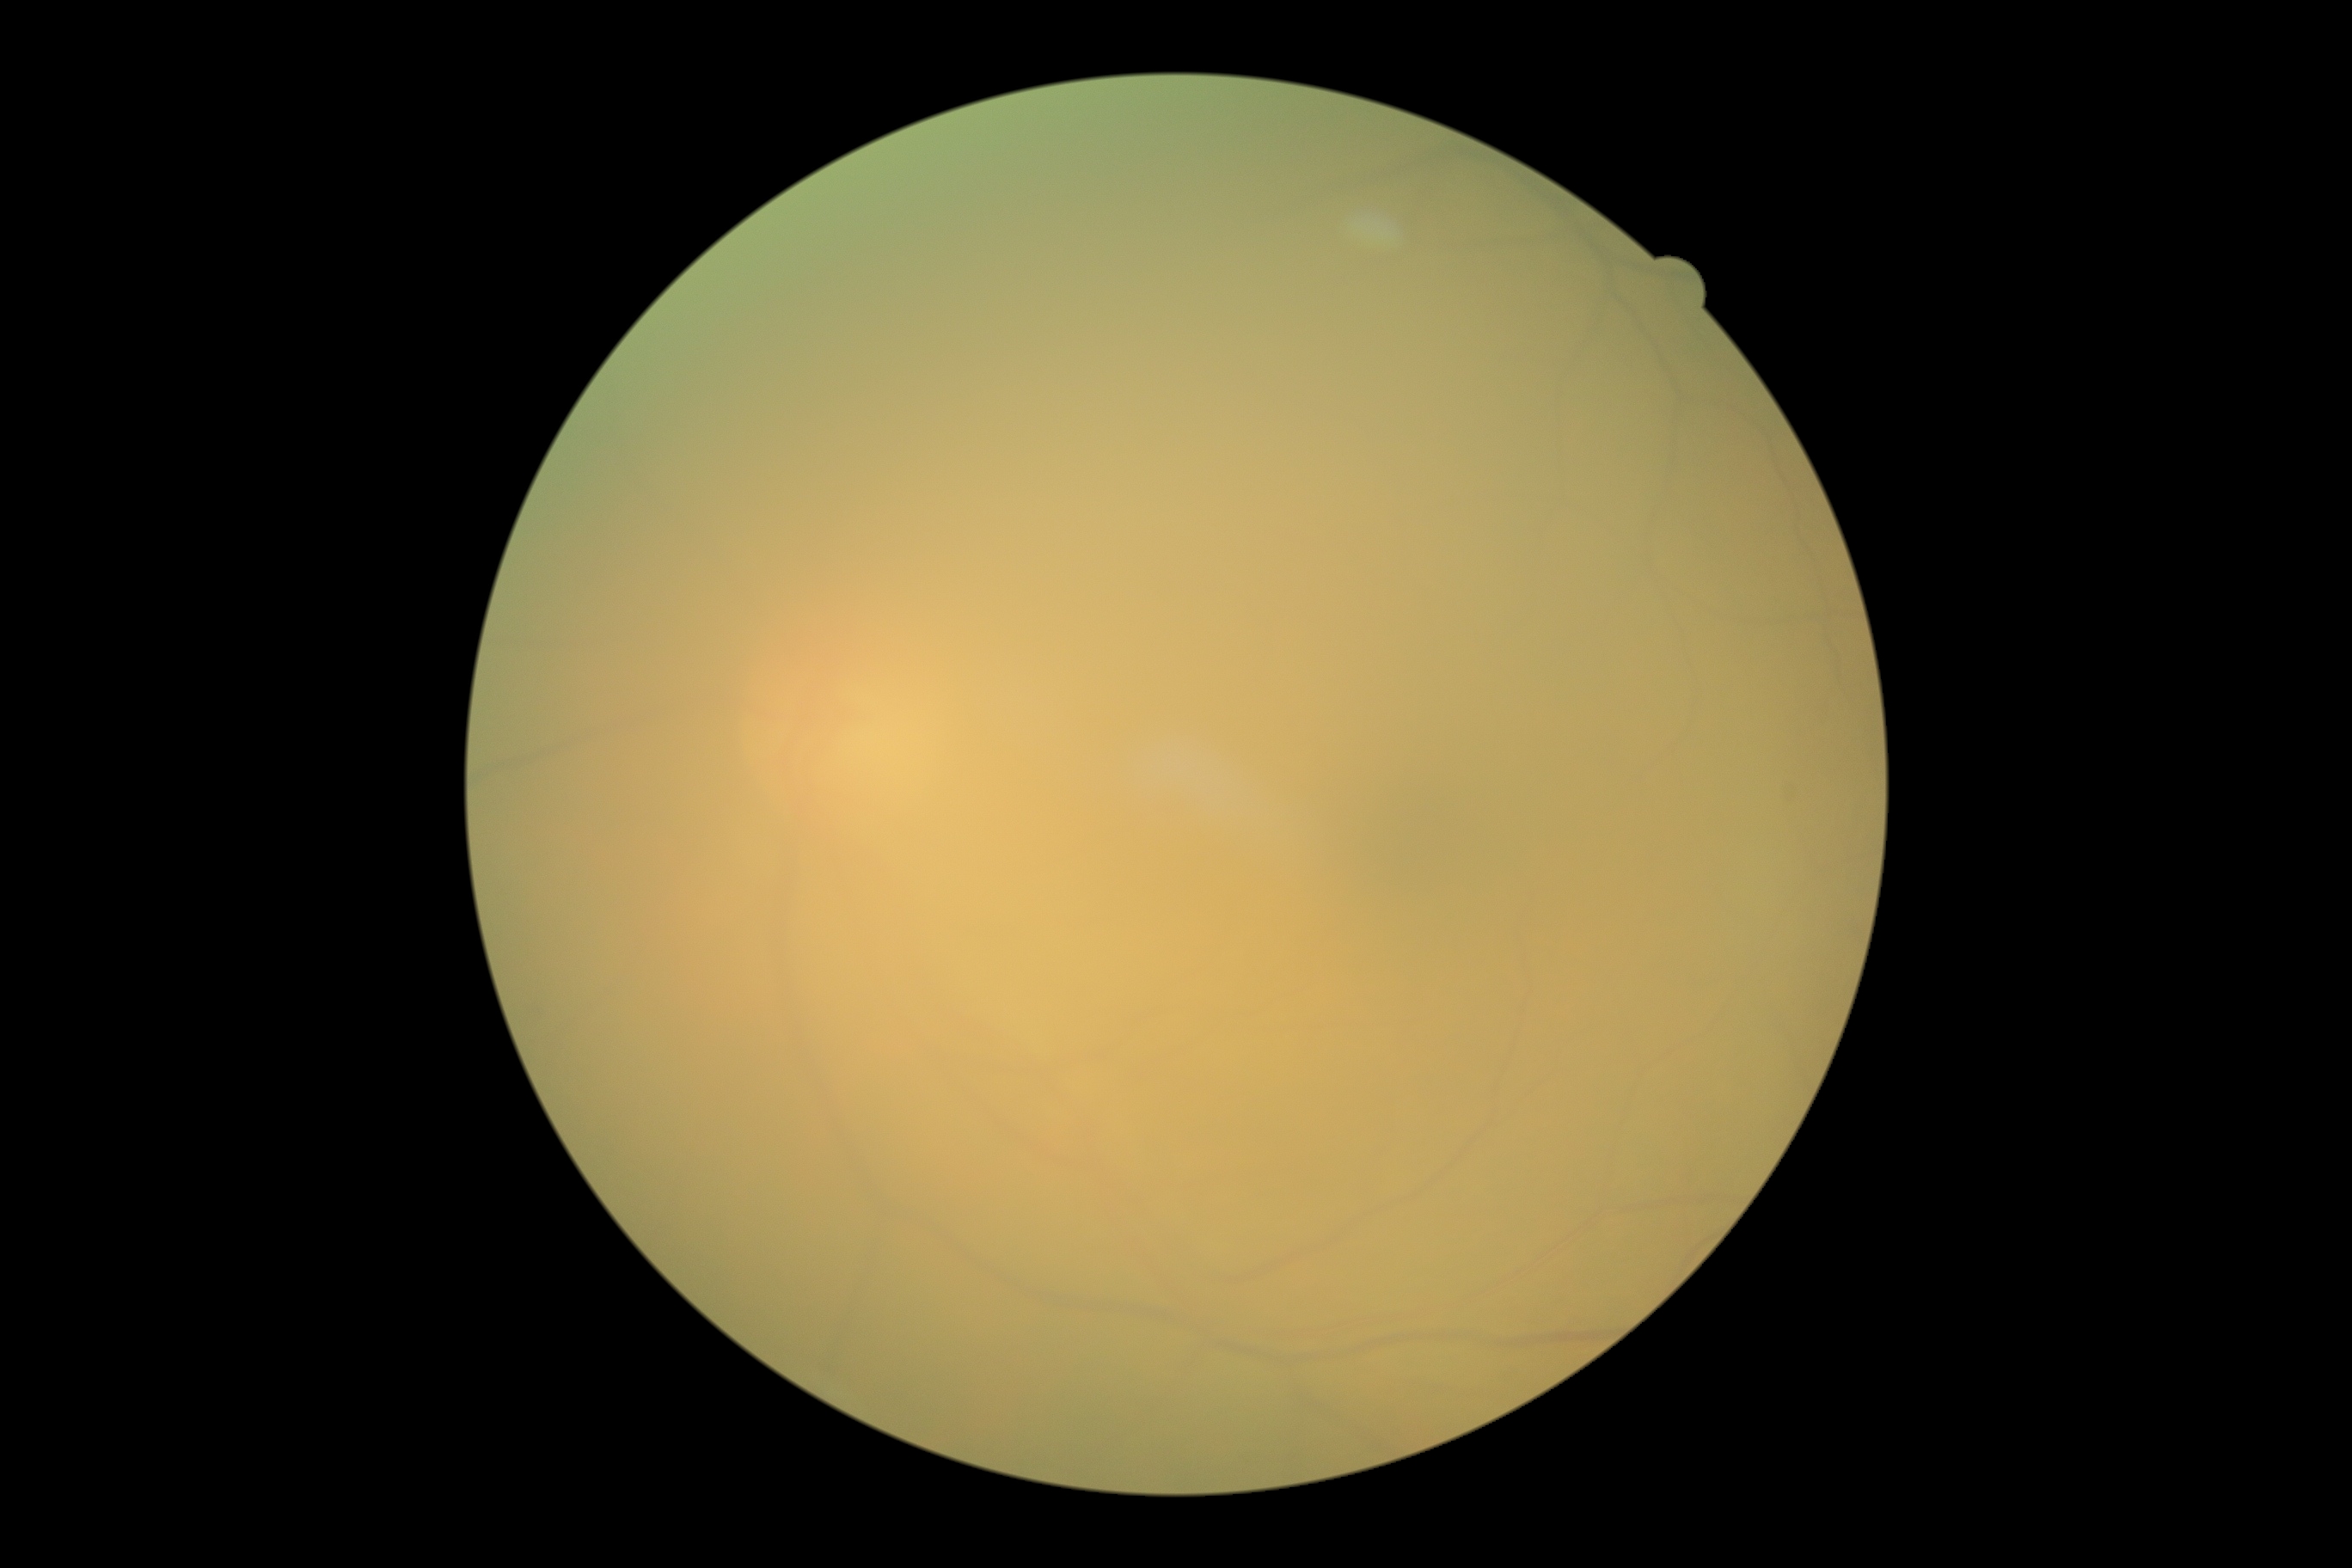

Retinopathy is ungradable. Image quality is insufficient for diabetic retinopathy assessment.